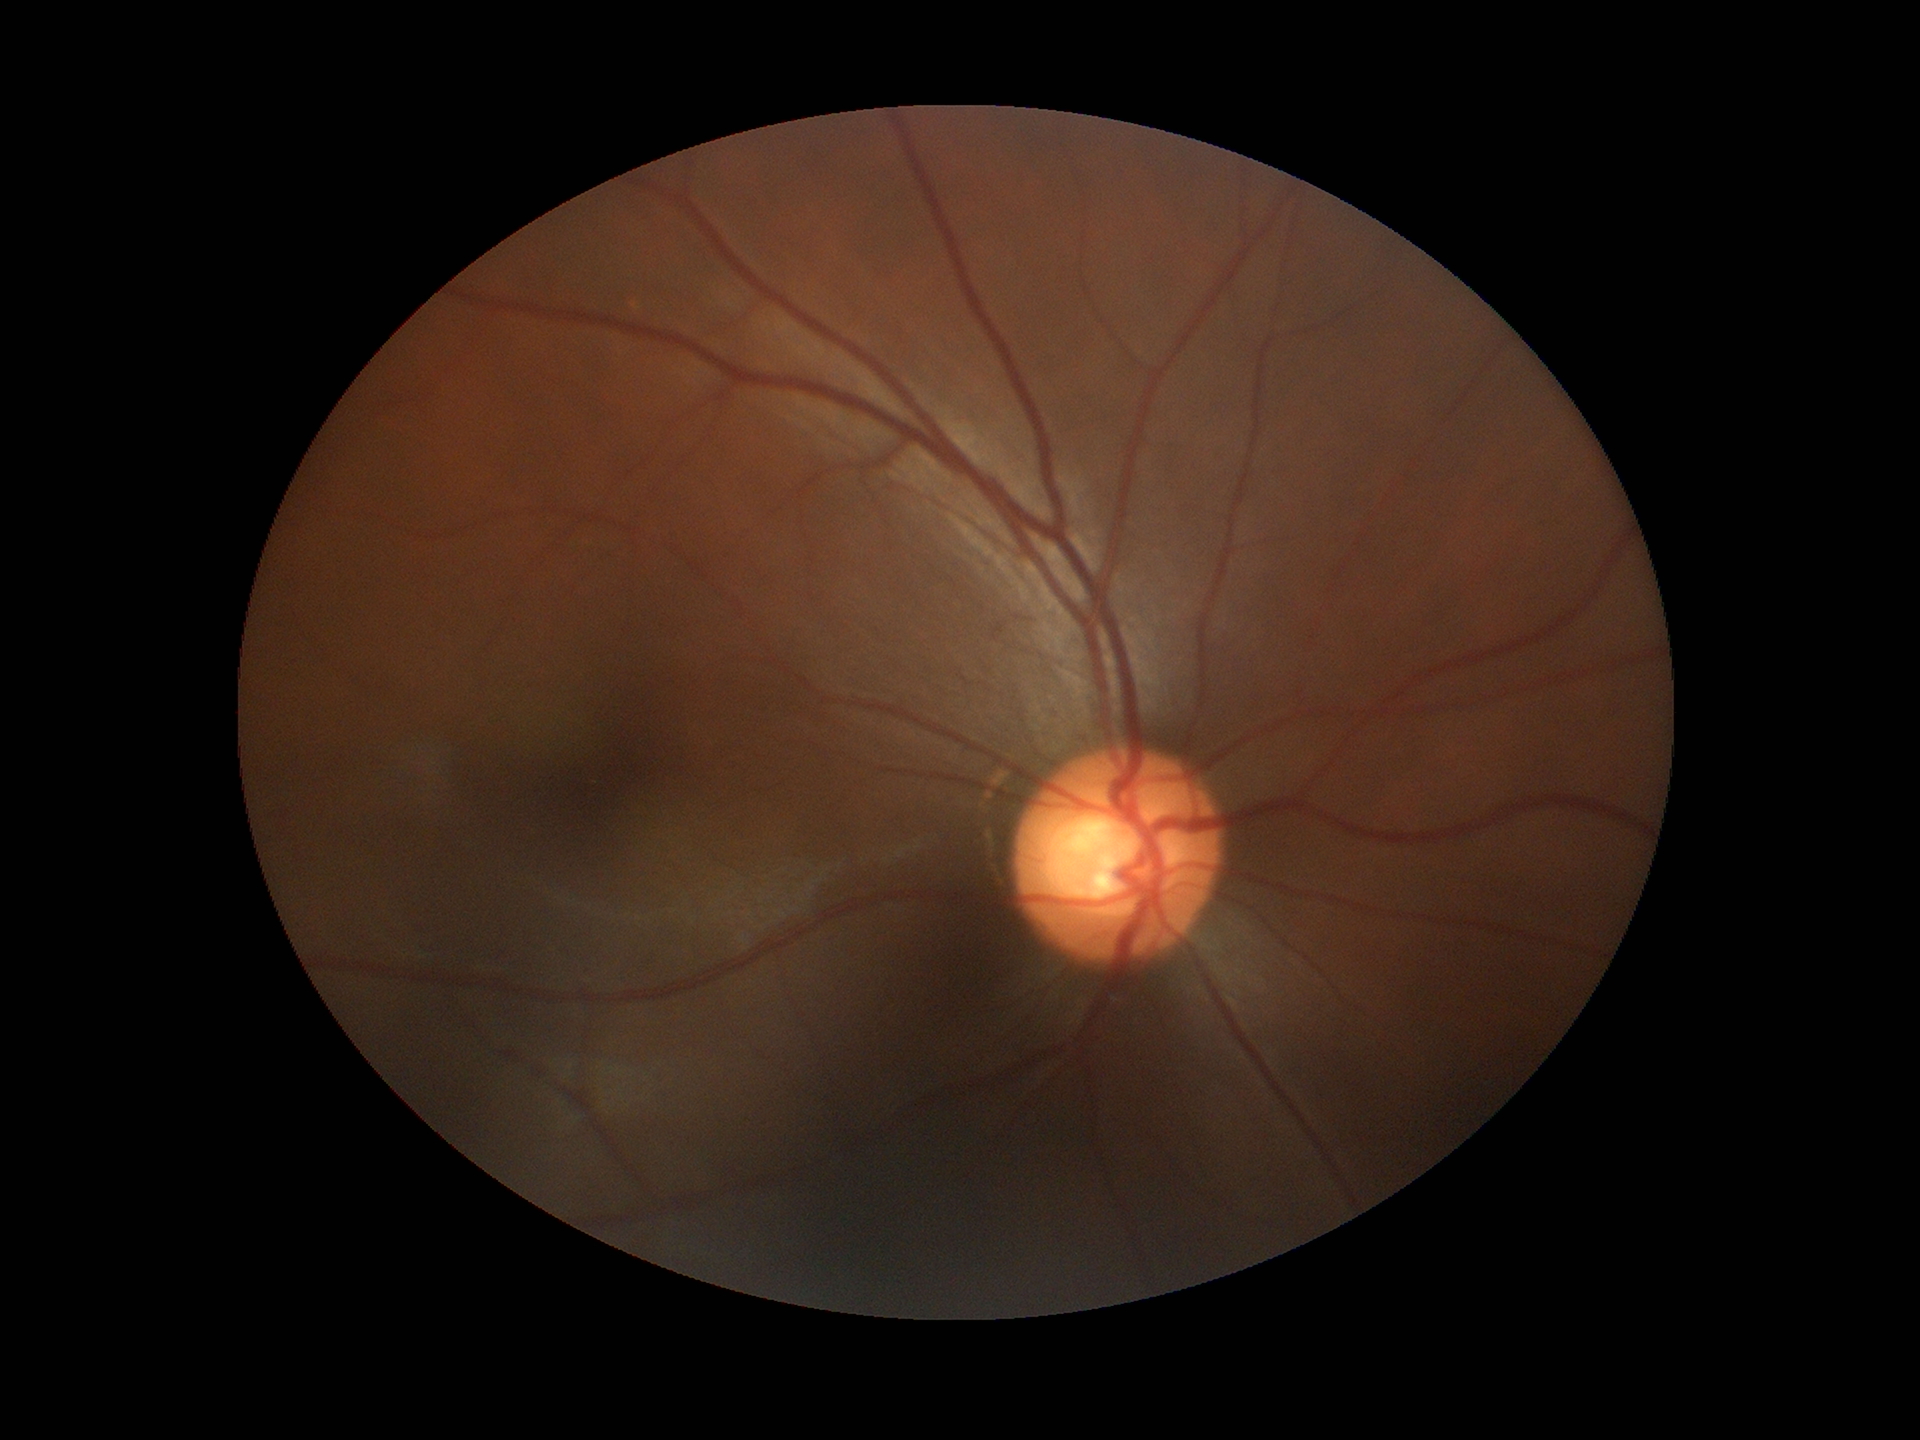
Glaucoma screening: suspect. Horizontal C/D ratio (HCDR) of 0.65. Vertical C/D ratio (VCDR): 0.60.